Retinal fundus photograph, 45° field of view: 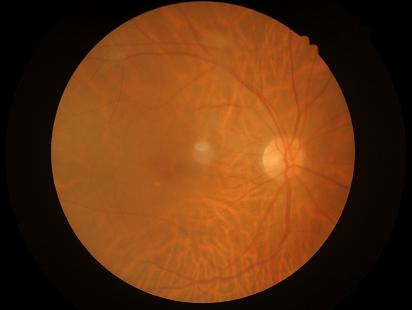
Vessels and details are readily distinguishable. Image quality is inadequate for diagnostic use. Noticeable blur in the optic disc, vessels, or background.